45° field of view — 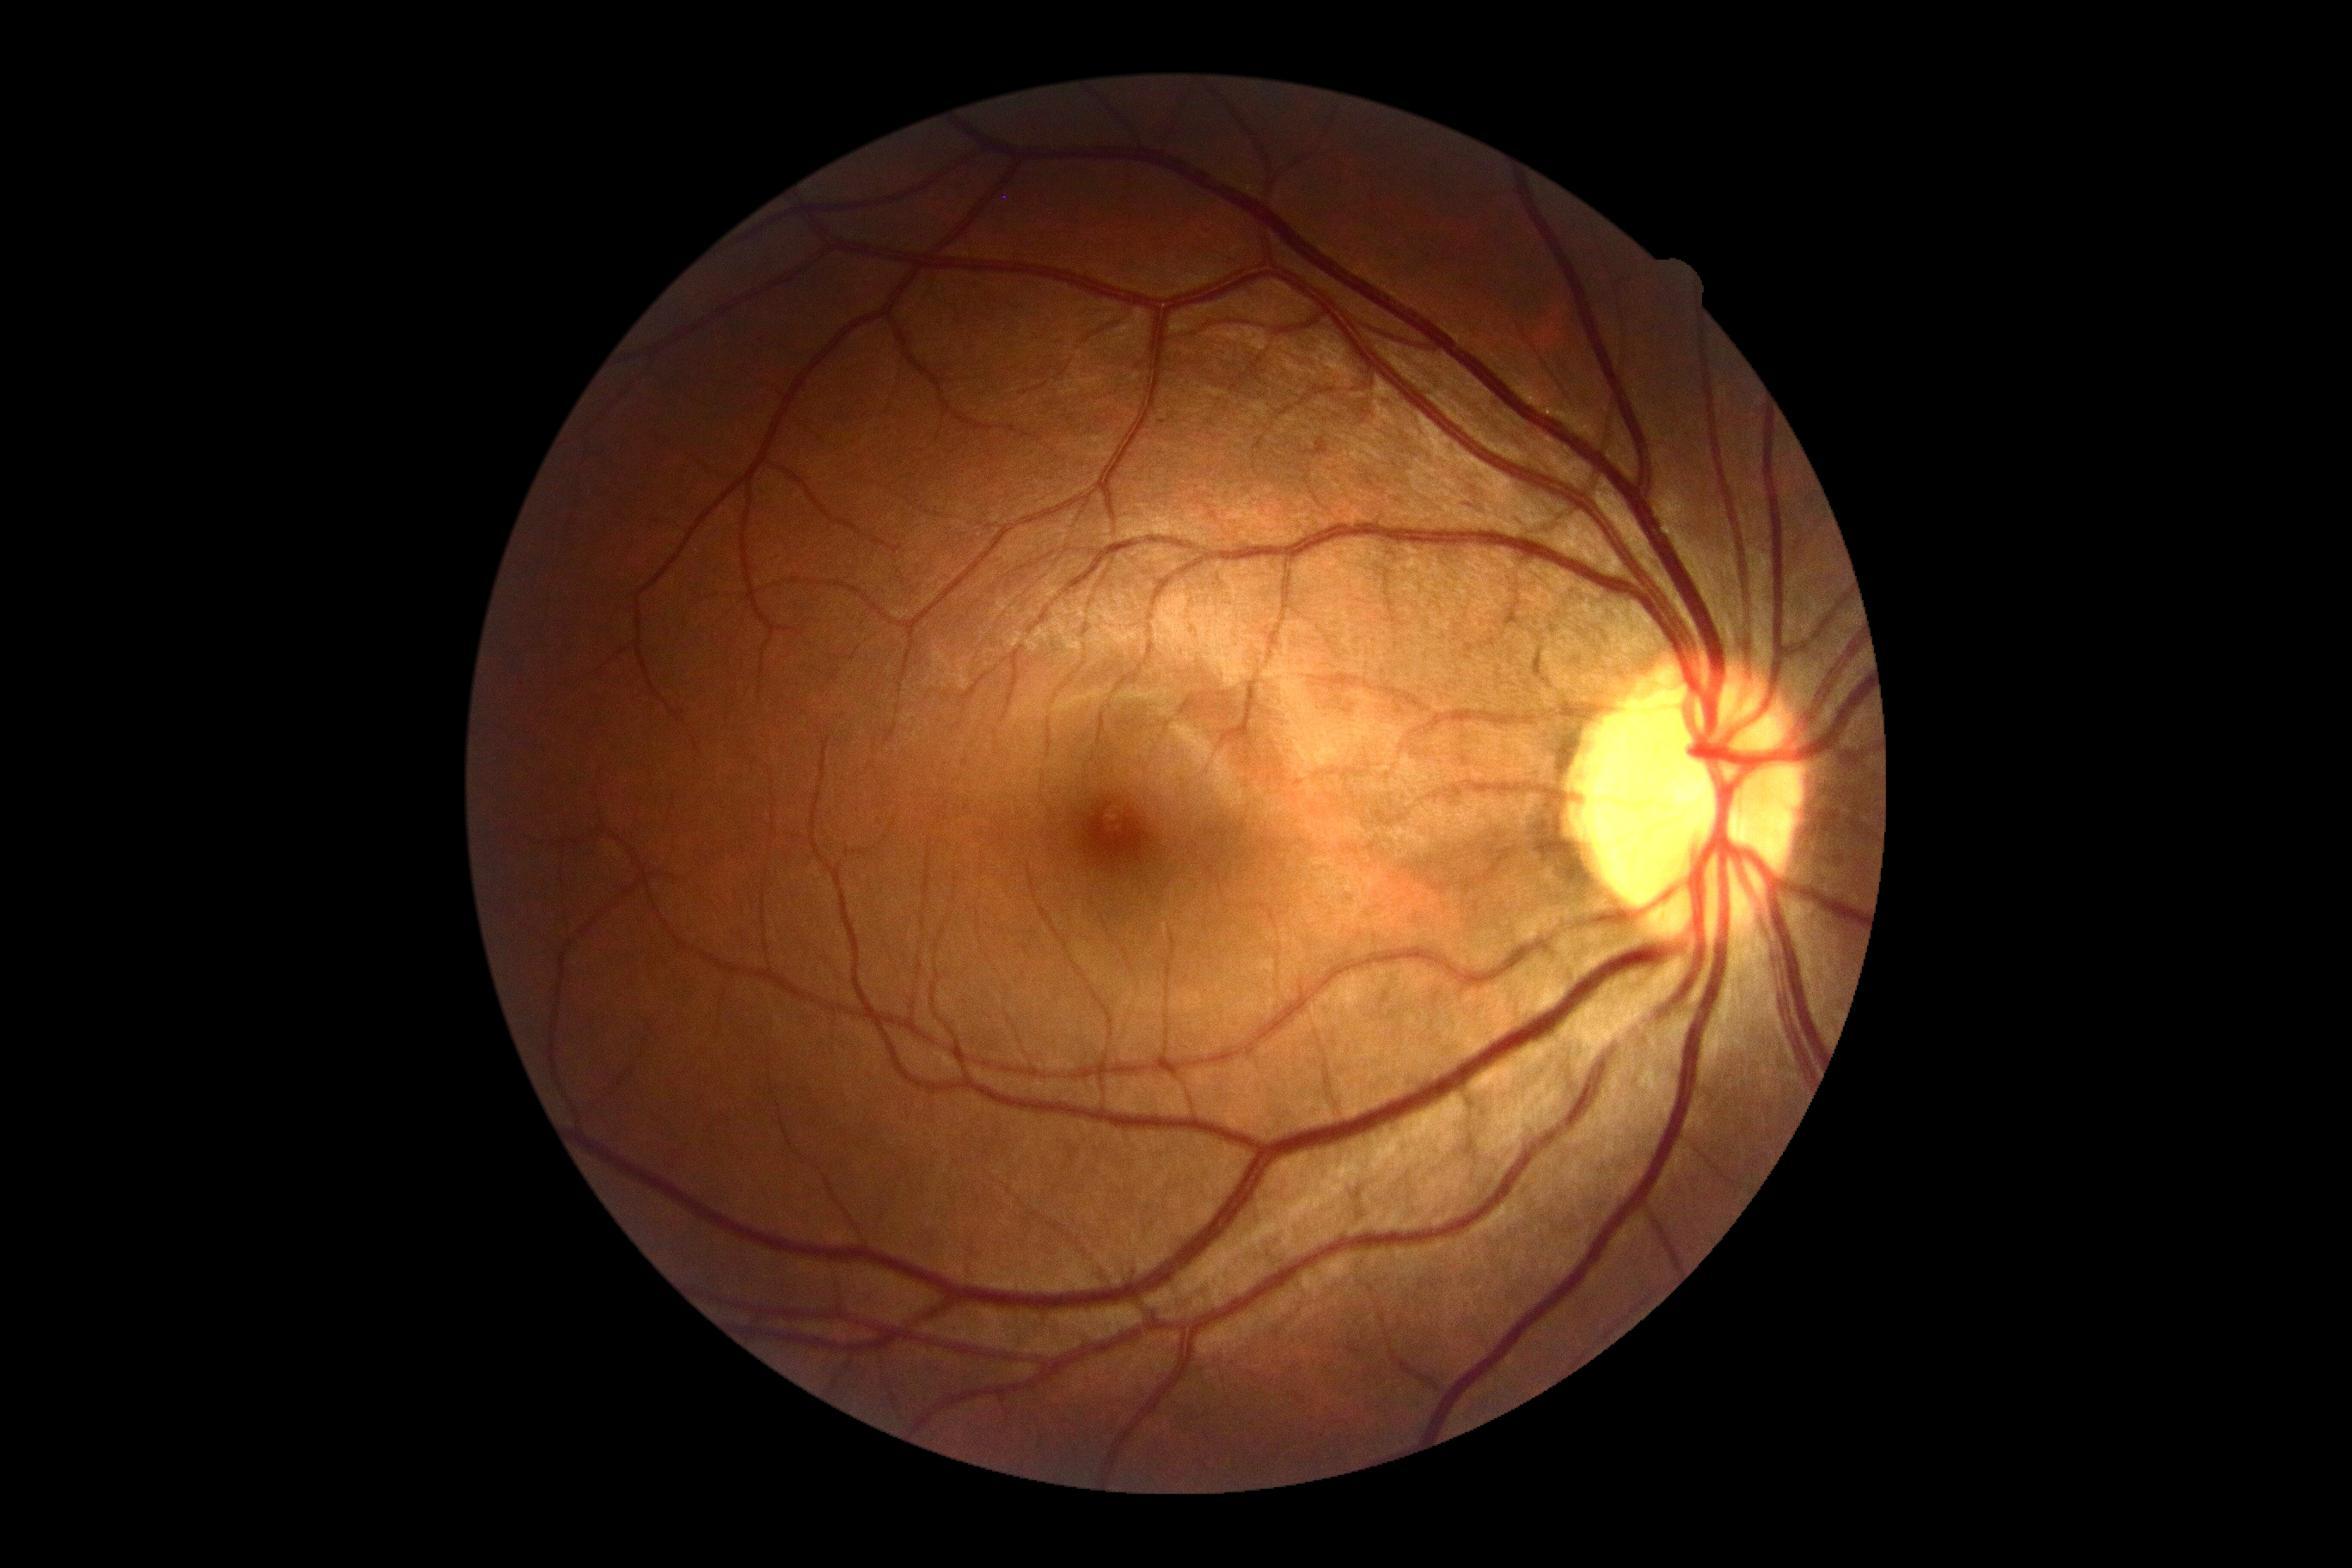

DR severity: no apparent diabetic retinopathy (grade 0).